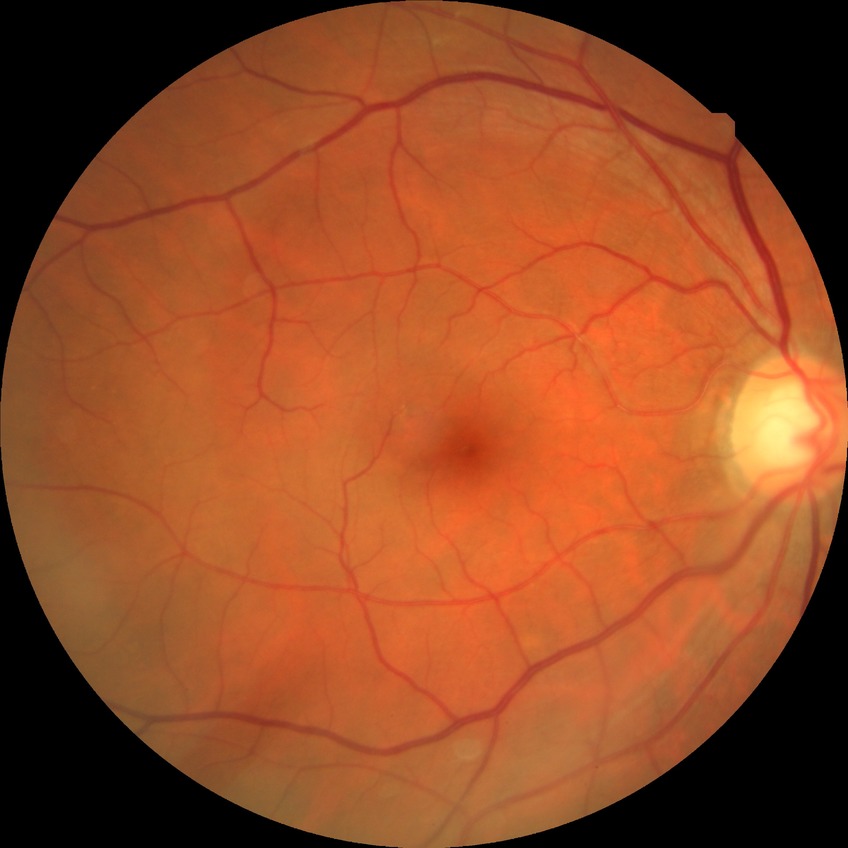

Diabetic retinopathy (DR) is NDR (no diabetic retinopathy).